Infant wide-field retinal image; acquired on the Phoenix ICON; 1240x1240px.
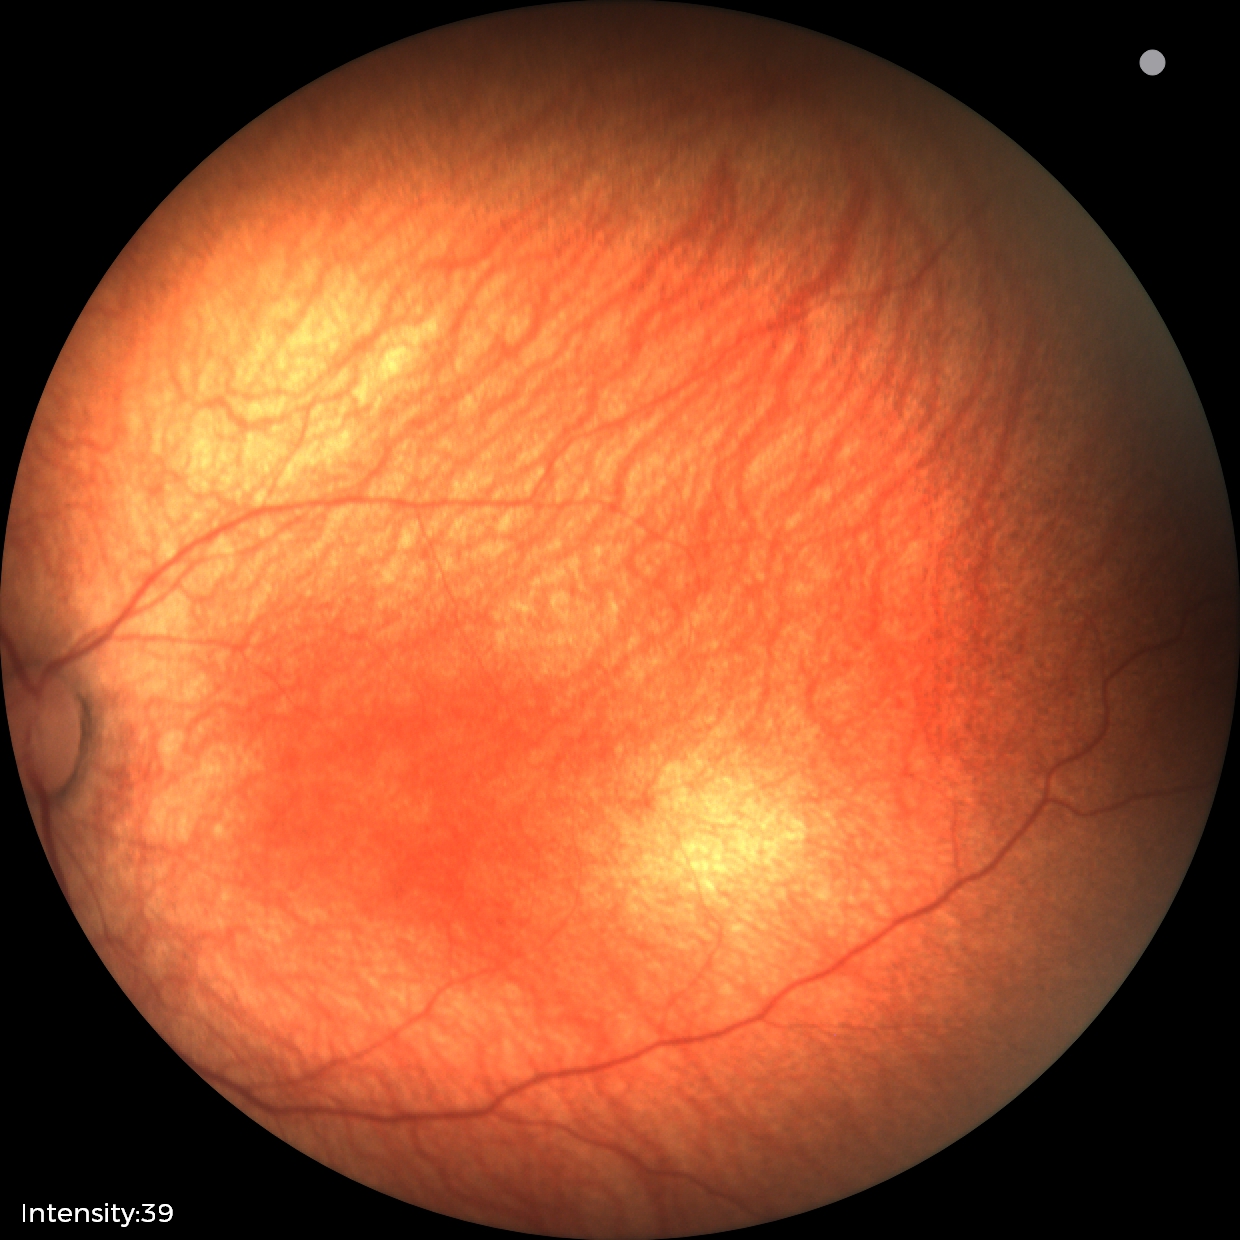

Screening examination with no abnormal retinal findings.